240x240, non-mydriatic acquisition
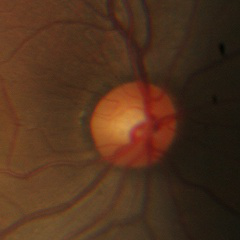 Glaucoma status: no evidence of glaucoma.